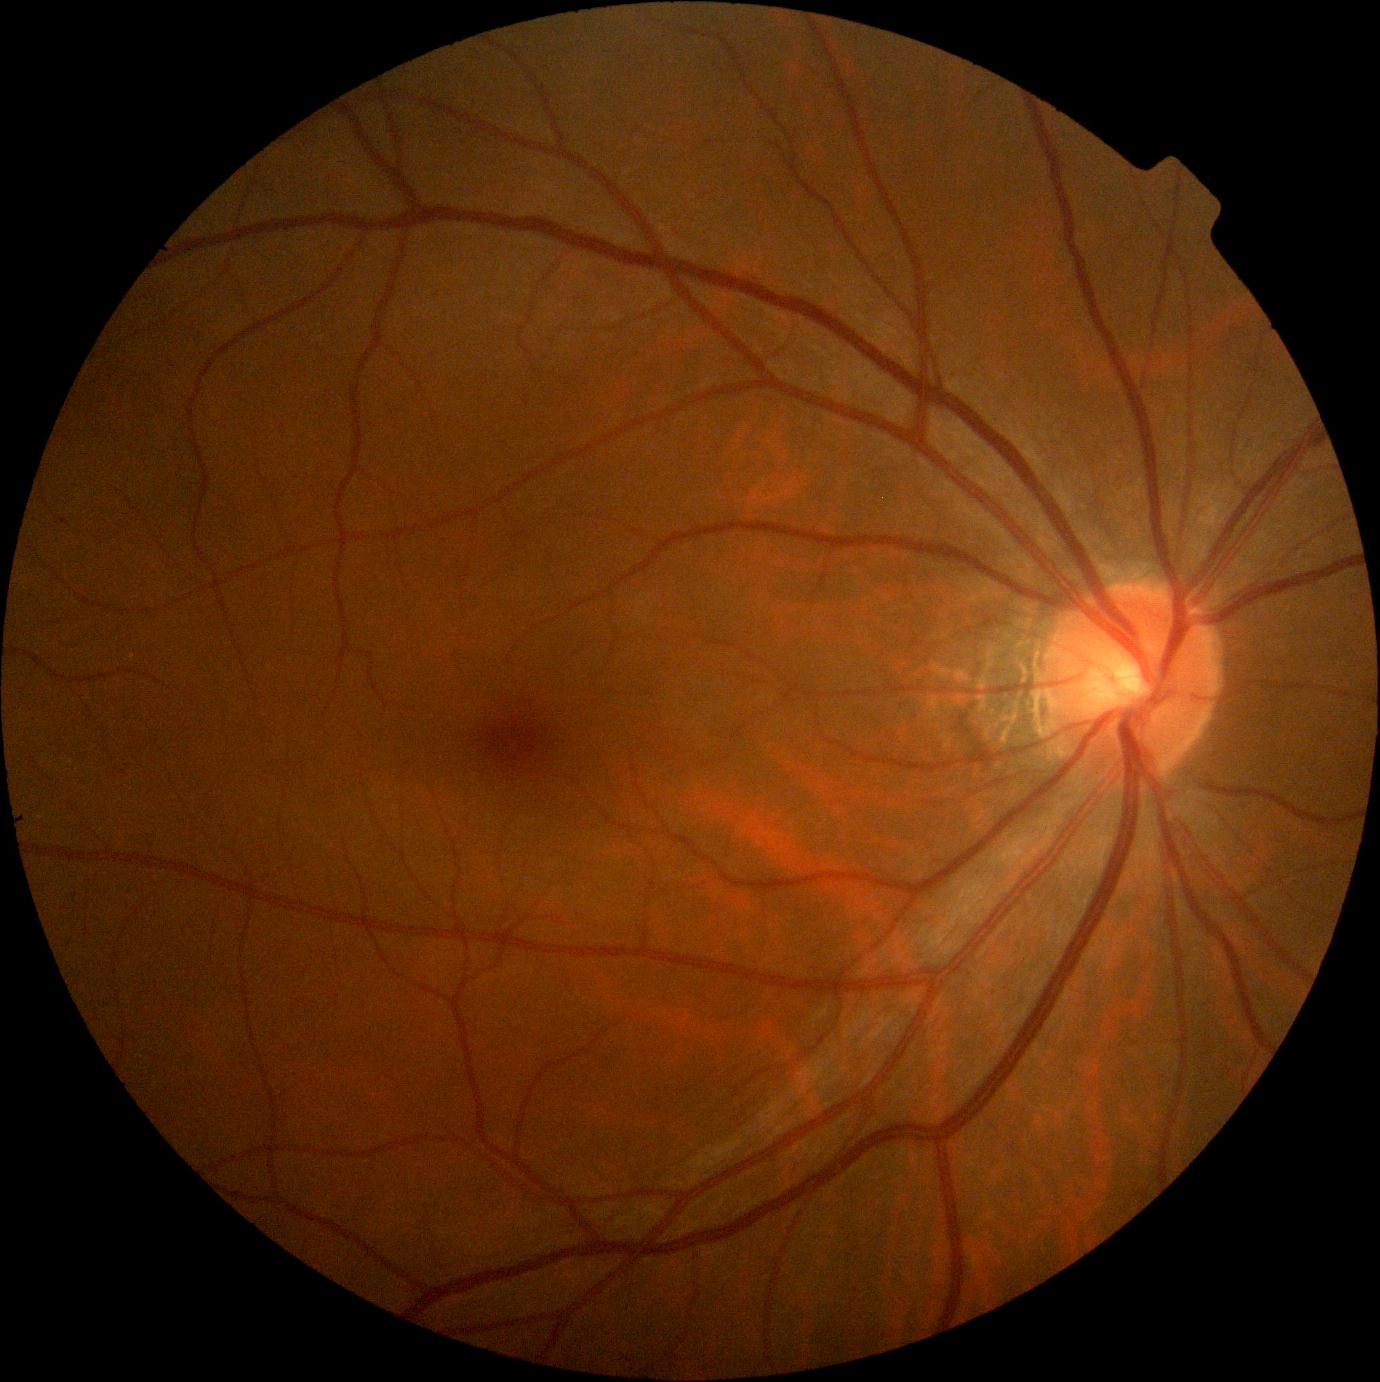

No diabetic retinal disease findings.
Diabetic retinopathy: grade 0 (no apparent retinopathy).